Centered on the macula: 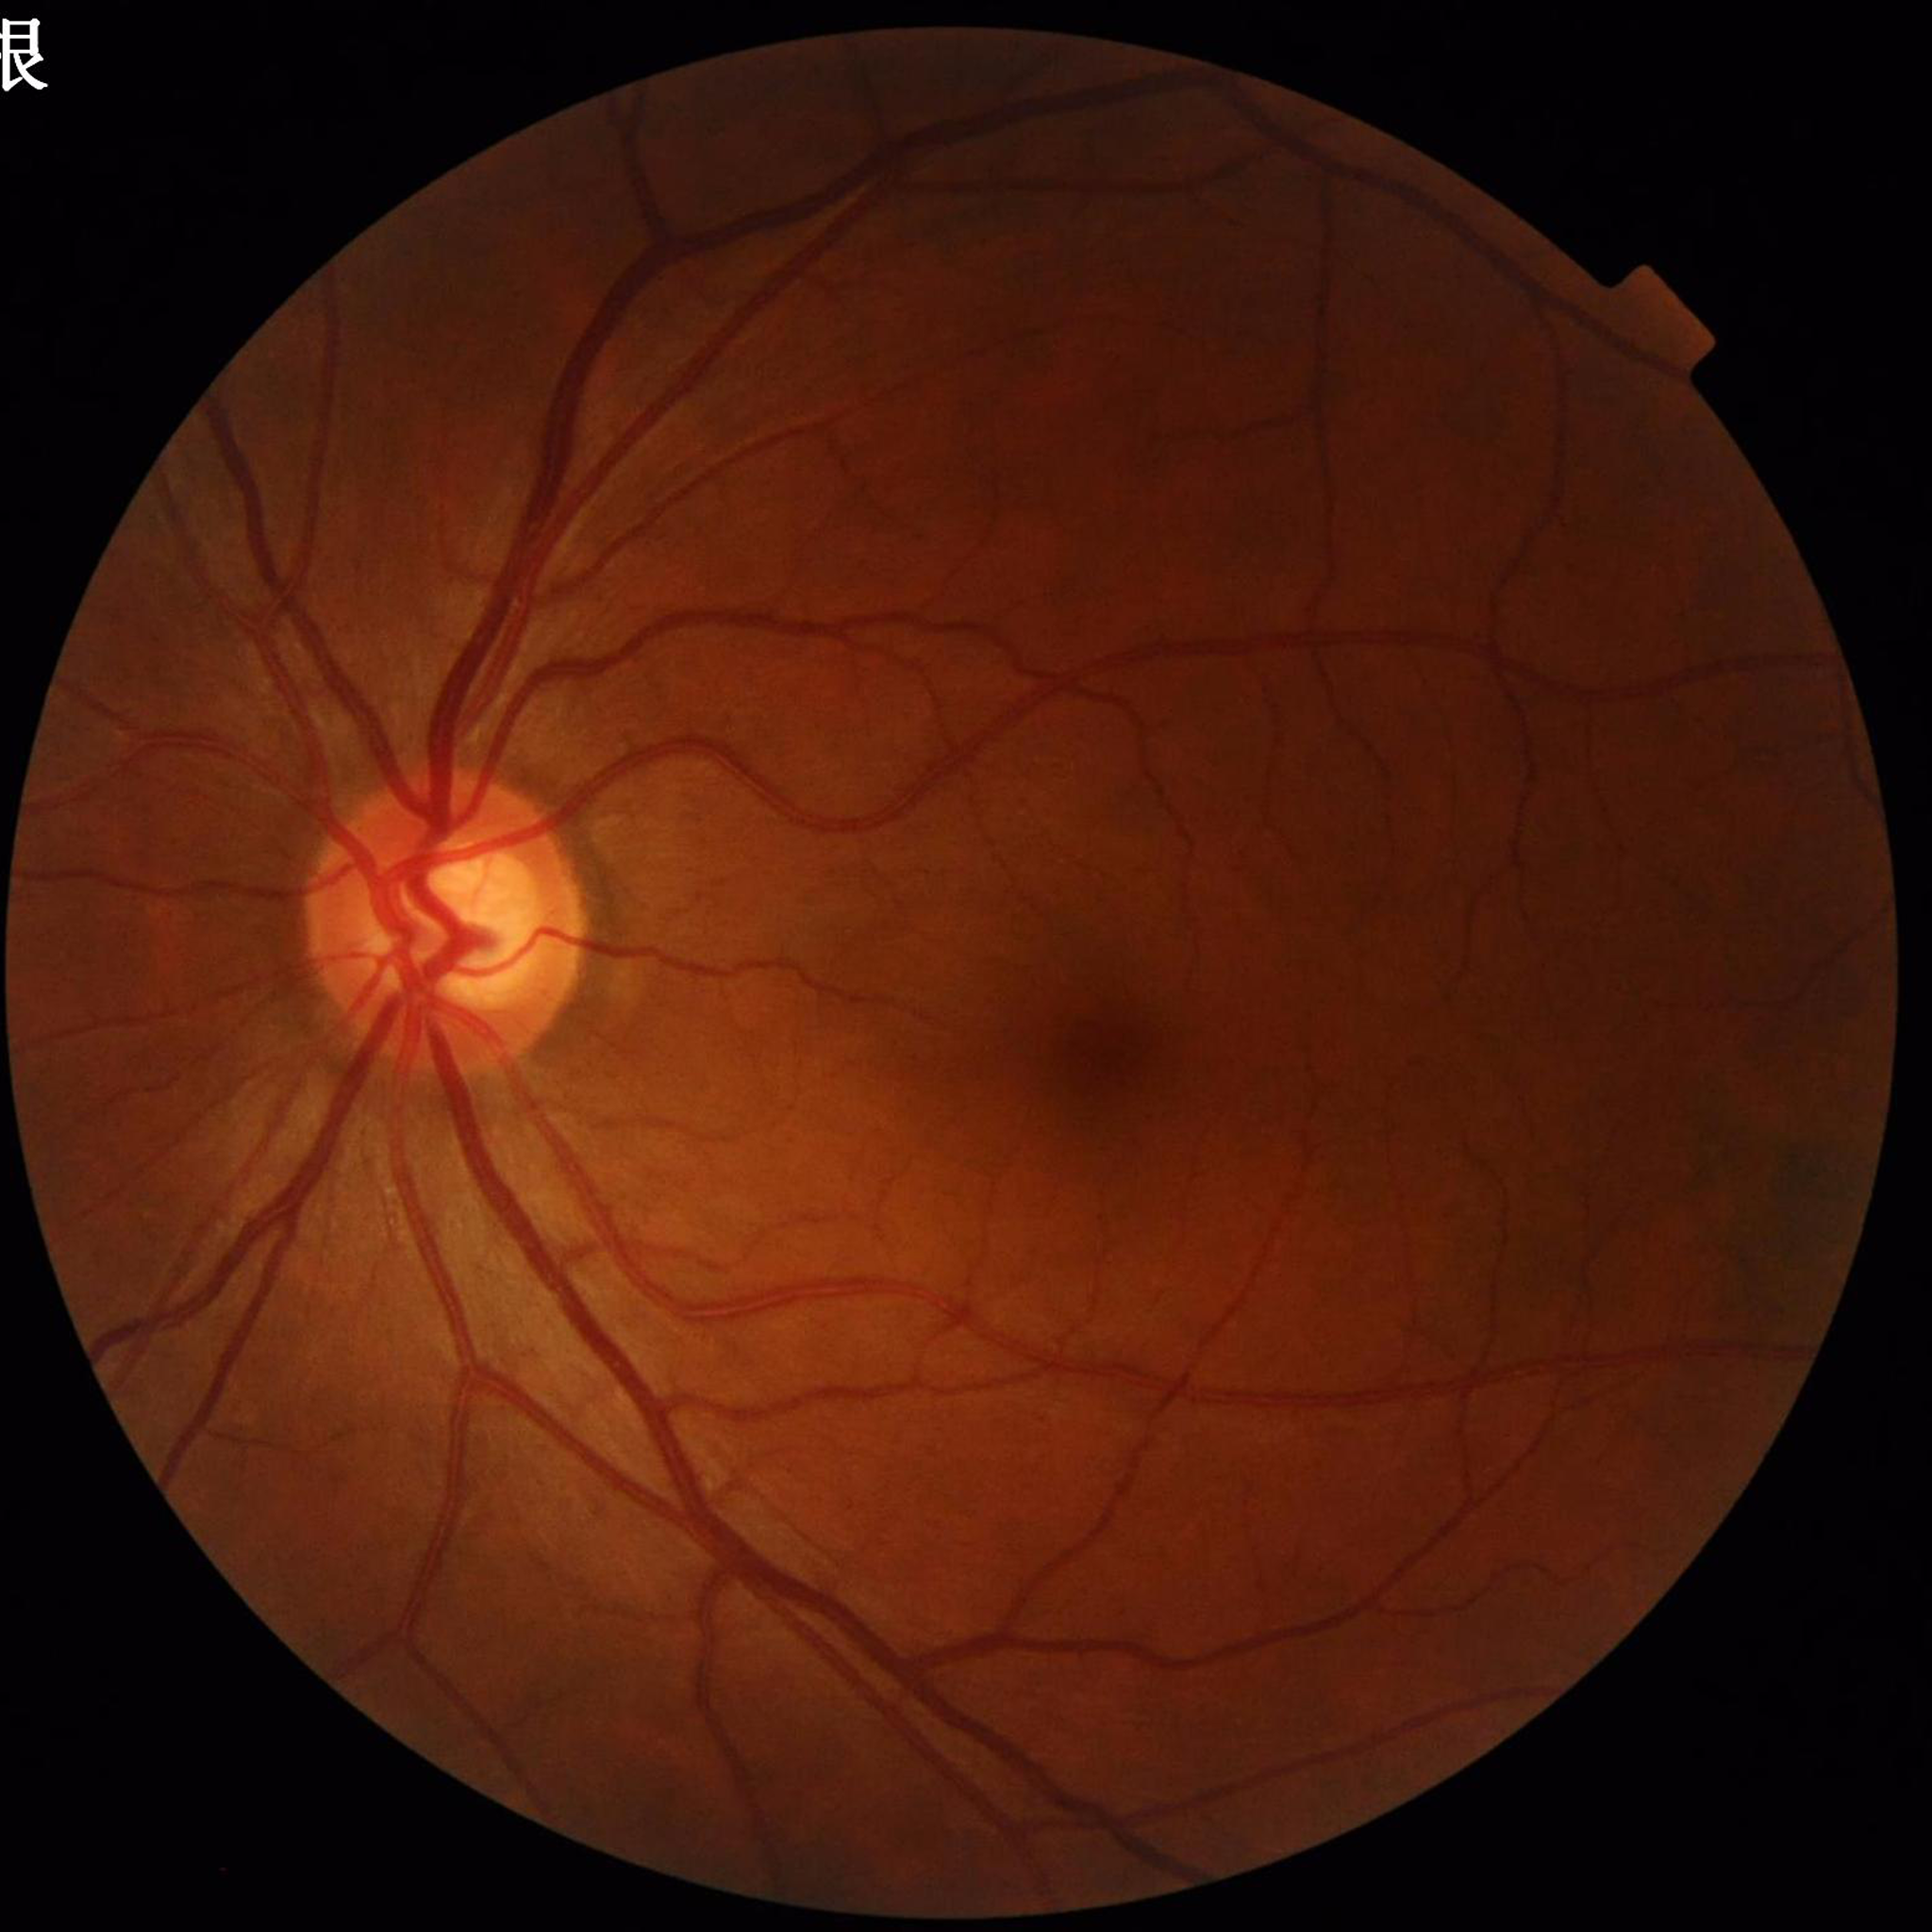

{
  "image_quality": "adequate",
  "diagnosis": "glaucoma"
}